Retinal fundus photograph. 1932x1923. FOV: 45 degrees — 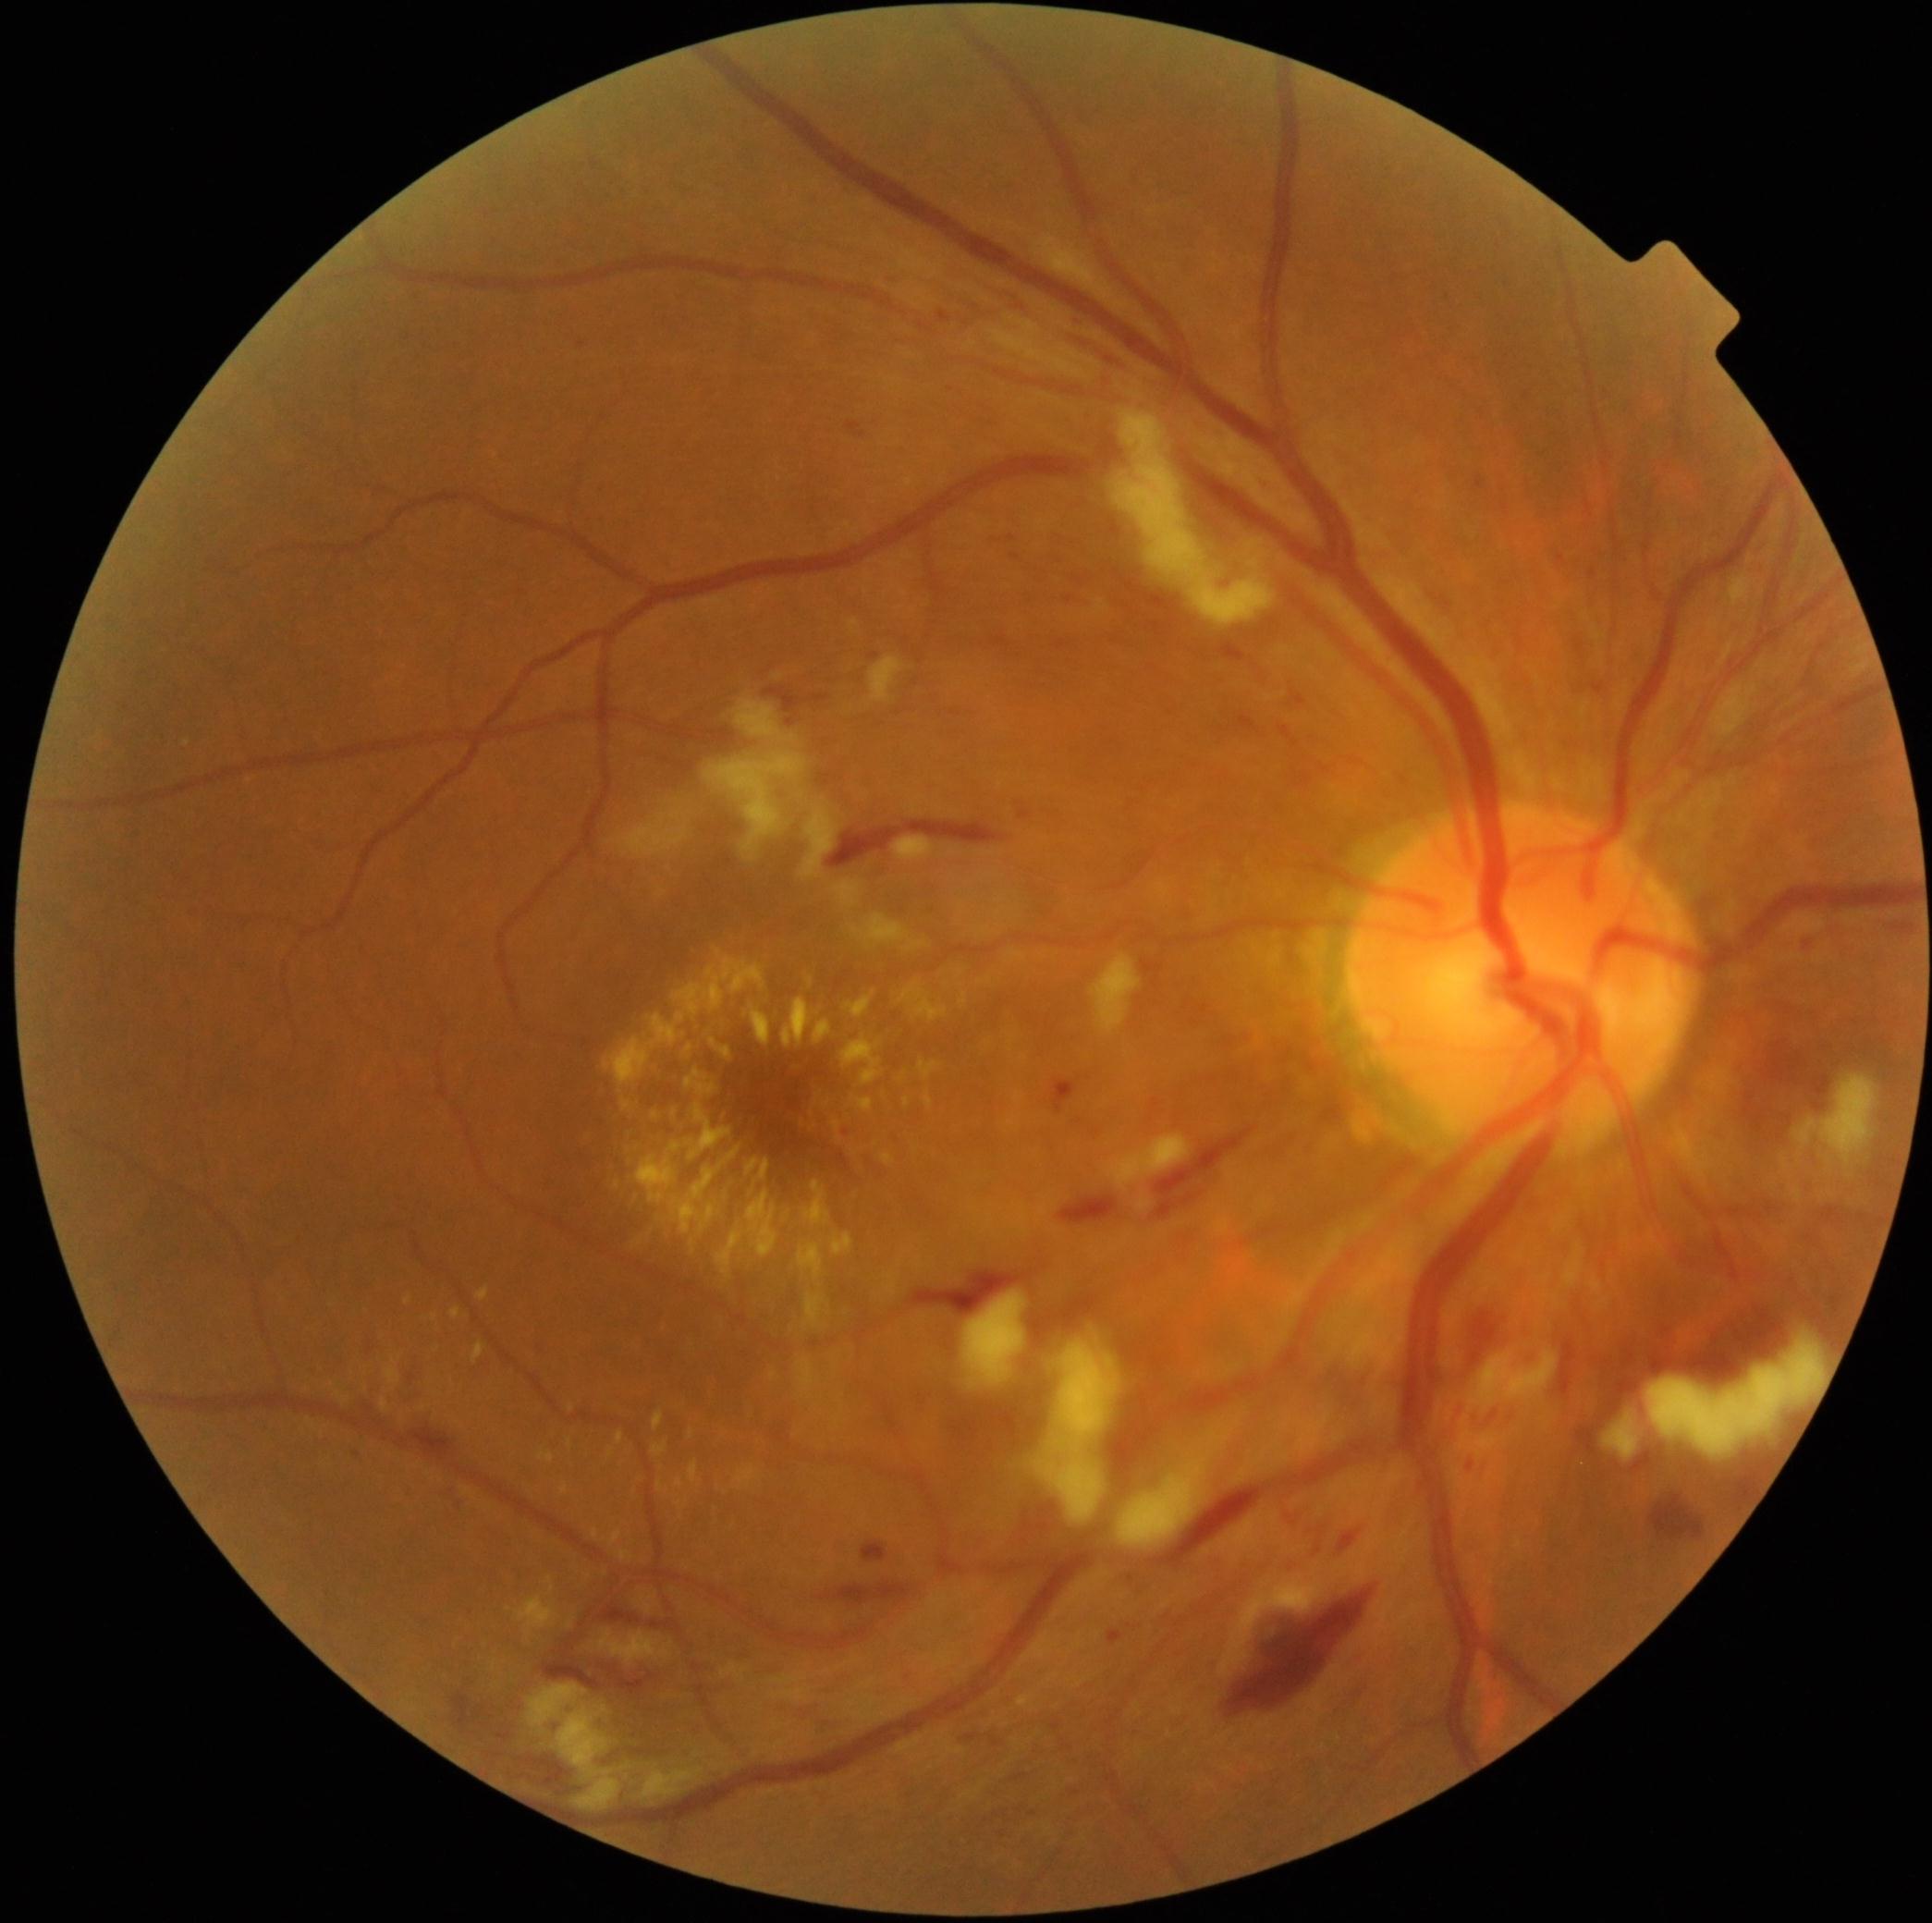 Retinopathy is severe NPDR (grade 3) — more than 20 intraretinal hemorrhages in each of 4 quadrants, definite venous beading in 2 or more quadrants, or prominent intraretinal microvascular abnormalities in 1 or more quadrants, with no signs of proliferative retinopathy
Representative lesions:
microaneurysms (subset): 348,1446,358,1460; 459,1493,469,1500; 1108,1629,1123,1645; 1590,570,1597,579; 1077,317,1084,325; 1462,1463,1475,1471; 1013,555,1021,560
Additional small microaneurysms near (847,1133); (1070,600); (581,344)
hemorrhages (subset): 1769,1042,1804,1084; 764,687,801,714; 1477,1400,1498,1437; 818,1720,850,1736; 909,1270,1028,1317; 1649,1493,1704,1540; 1883,921,1915,934; 836,1581,911,1605; 1647,1306,1786,1383; 1013,1773,1028,1781; 1302,771,1313,786; 1219,643,1247,663; 1814,1076,1829,1095; 1236,716,1258,732
hard exudates (subset): 690,1429,695,1437; 635,1104,741,1235; 405,1296,412,1304; 882,1155,895,1164; 617,1431,624,1444; 611,1530,622,1546; 845,992,876,1018; 900,985,948,1022; 803,1181,832,1226; 652,1440,669,1455; 748,1158,761,1173; 652,1111,659,1119; 385,1358,401,1385
Additional small hard exudates near (812,1114); (436,1317); (693,1243)
soft exudates (subset): 1118,1418,1241,1548; 1793,1074,1881,1171; 1090,952,1143,1035; 869,655,906,704; 1468,1349,1558,1415; 852,913,927,952; 801,805,836,880; 1219,1562,1329,1678; 893,837,935,861; 1647,1336,1828,1460